Color fundus image: 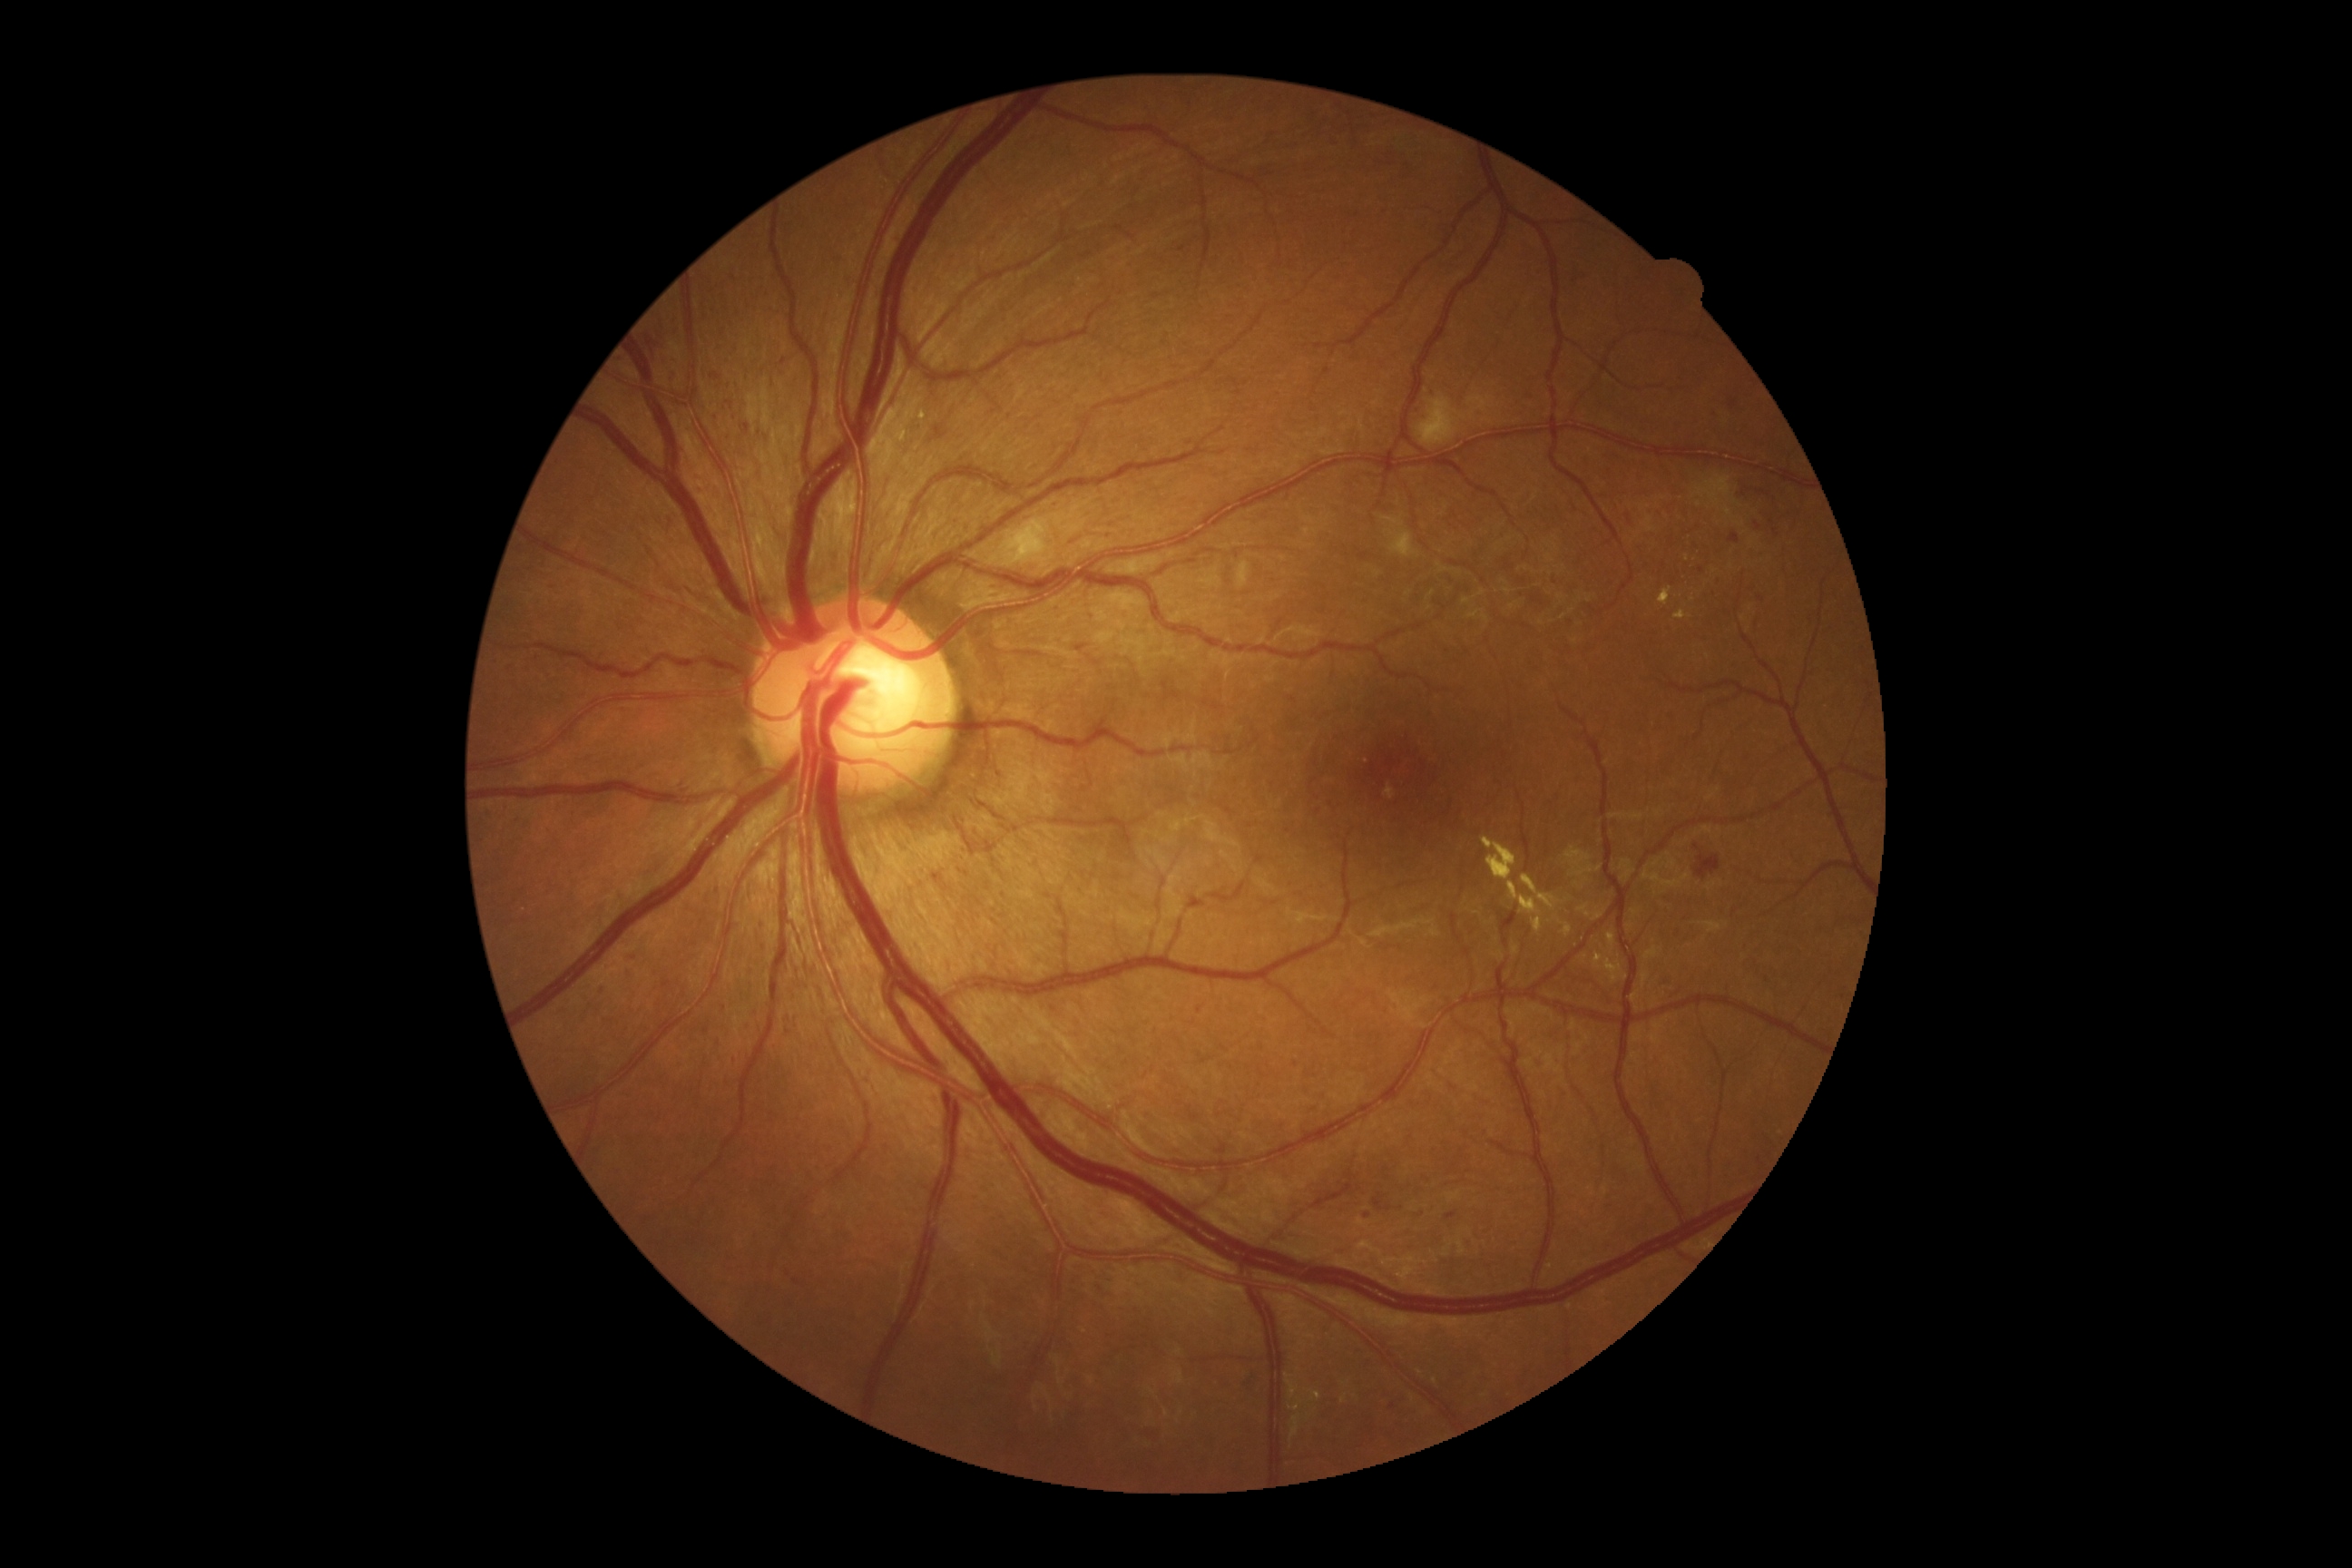

DR stage: 2/4.
HEs are located at l=647, t=338, r=654, b=362; l=1696, t=854, r=1720, b=879.
EXs are present, including at l=1342, t=1395, r=1348, b=1404; l=921, t=411, r=926, b=420; l=1522, t=876, r=1560, b=912; l=1674, t=611, r=1692, b=620; l=1482, t=838, r=1518, b=881; l=901, t=433, r=906, b=442; l=1578, t=905, r=1607, b=921; l=1594, t=954, r=1603, b=970; l=1605, t=959, r=1629, b=983; l=1560, t=921, r=1573, b=937; l=1308, t=1389, r=1320, b=1402; l=1291, t=1415, r=1302, b=1442; l=1289, t=1400, r=1302, b=1413; l=1507, t=881, r=1542, b=934; l=1607, t=934, r=1616, b=952; l=1660, t=587, r=1672, b=607; l=1288, t=1382, r=1298, b=1400.
Smaller EXs around pt(1309, 1416); pt(1288, 1376).
MAs are present, including at l=1627, t=514, r=1631, b=522; l=930, t=424, r=950, b=444; l=1729, t=533, r=1740, b=544; l=1446, t=1211, r=1458, b=1220; l=1364, t=1211, r=1371, b=1220; l=1756, t=522, r=1761, b=531; l=743, t=424, r=752, b=435; l=710, t=373, r=721, b=380; l=1324, t=369, r=1331, b=377; l=600, t=986, r=607, b=995; l=1075, t=643, r=1090, b=654; l=703, t=1024, r=710, b=1034.
Smaller MAs around pt(1295, 1064); pt(1182, 250); pt(1776, 532); pt(729, 404); pt(1697, 847); pt(1393, 1406); pt(632, 958); pt(723, 1008).
SEs are located at l=1416, t=397, r=1467, b=447; l=1001, t=518, r=1052, b=567; l=1237, t=562, r=1250, b=589; l=1380, t=516, r=1420, b=558.